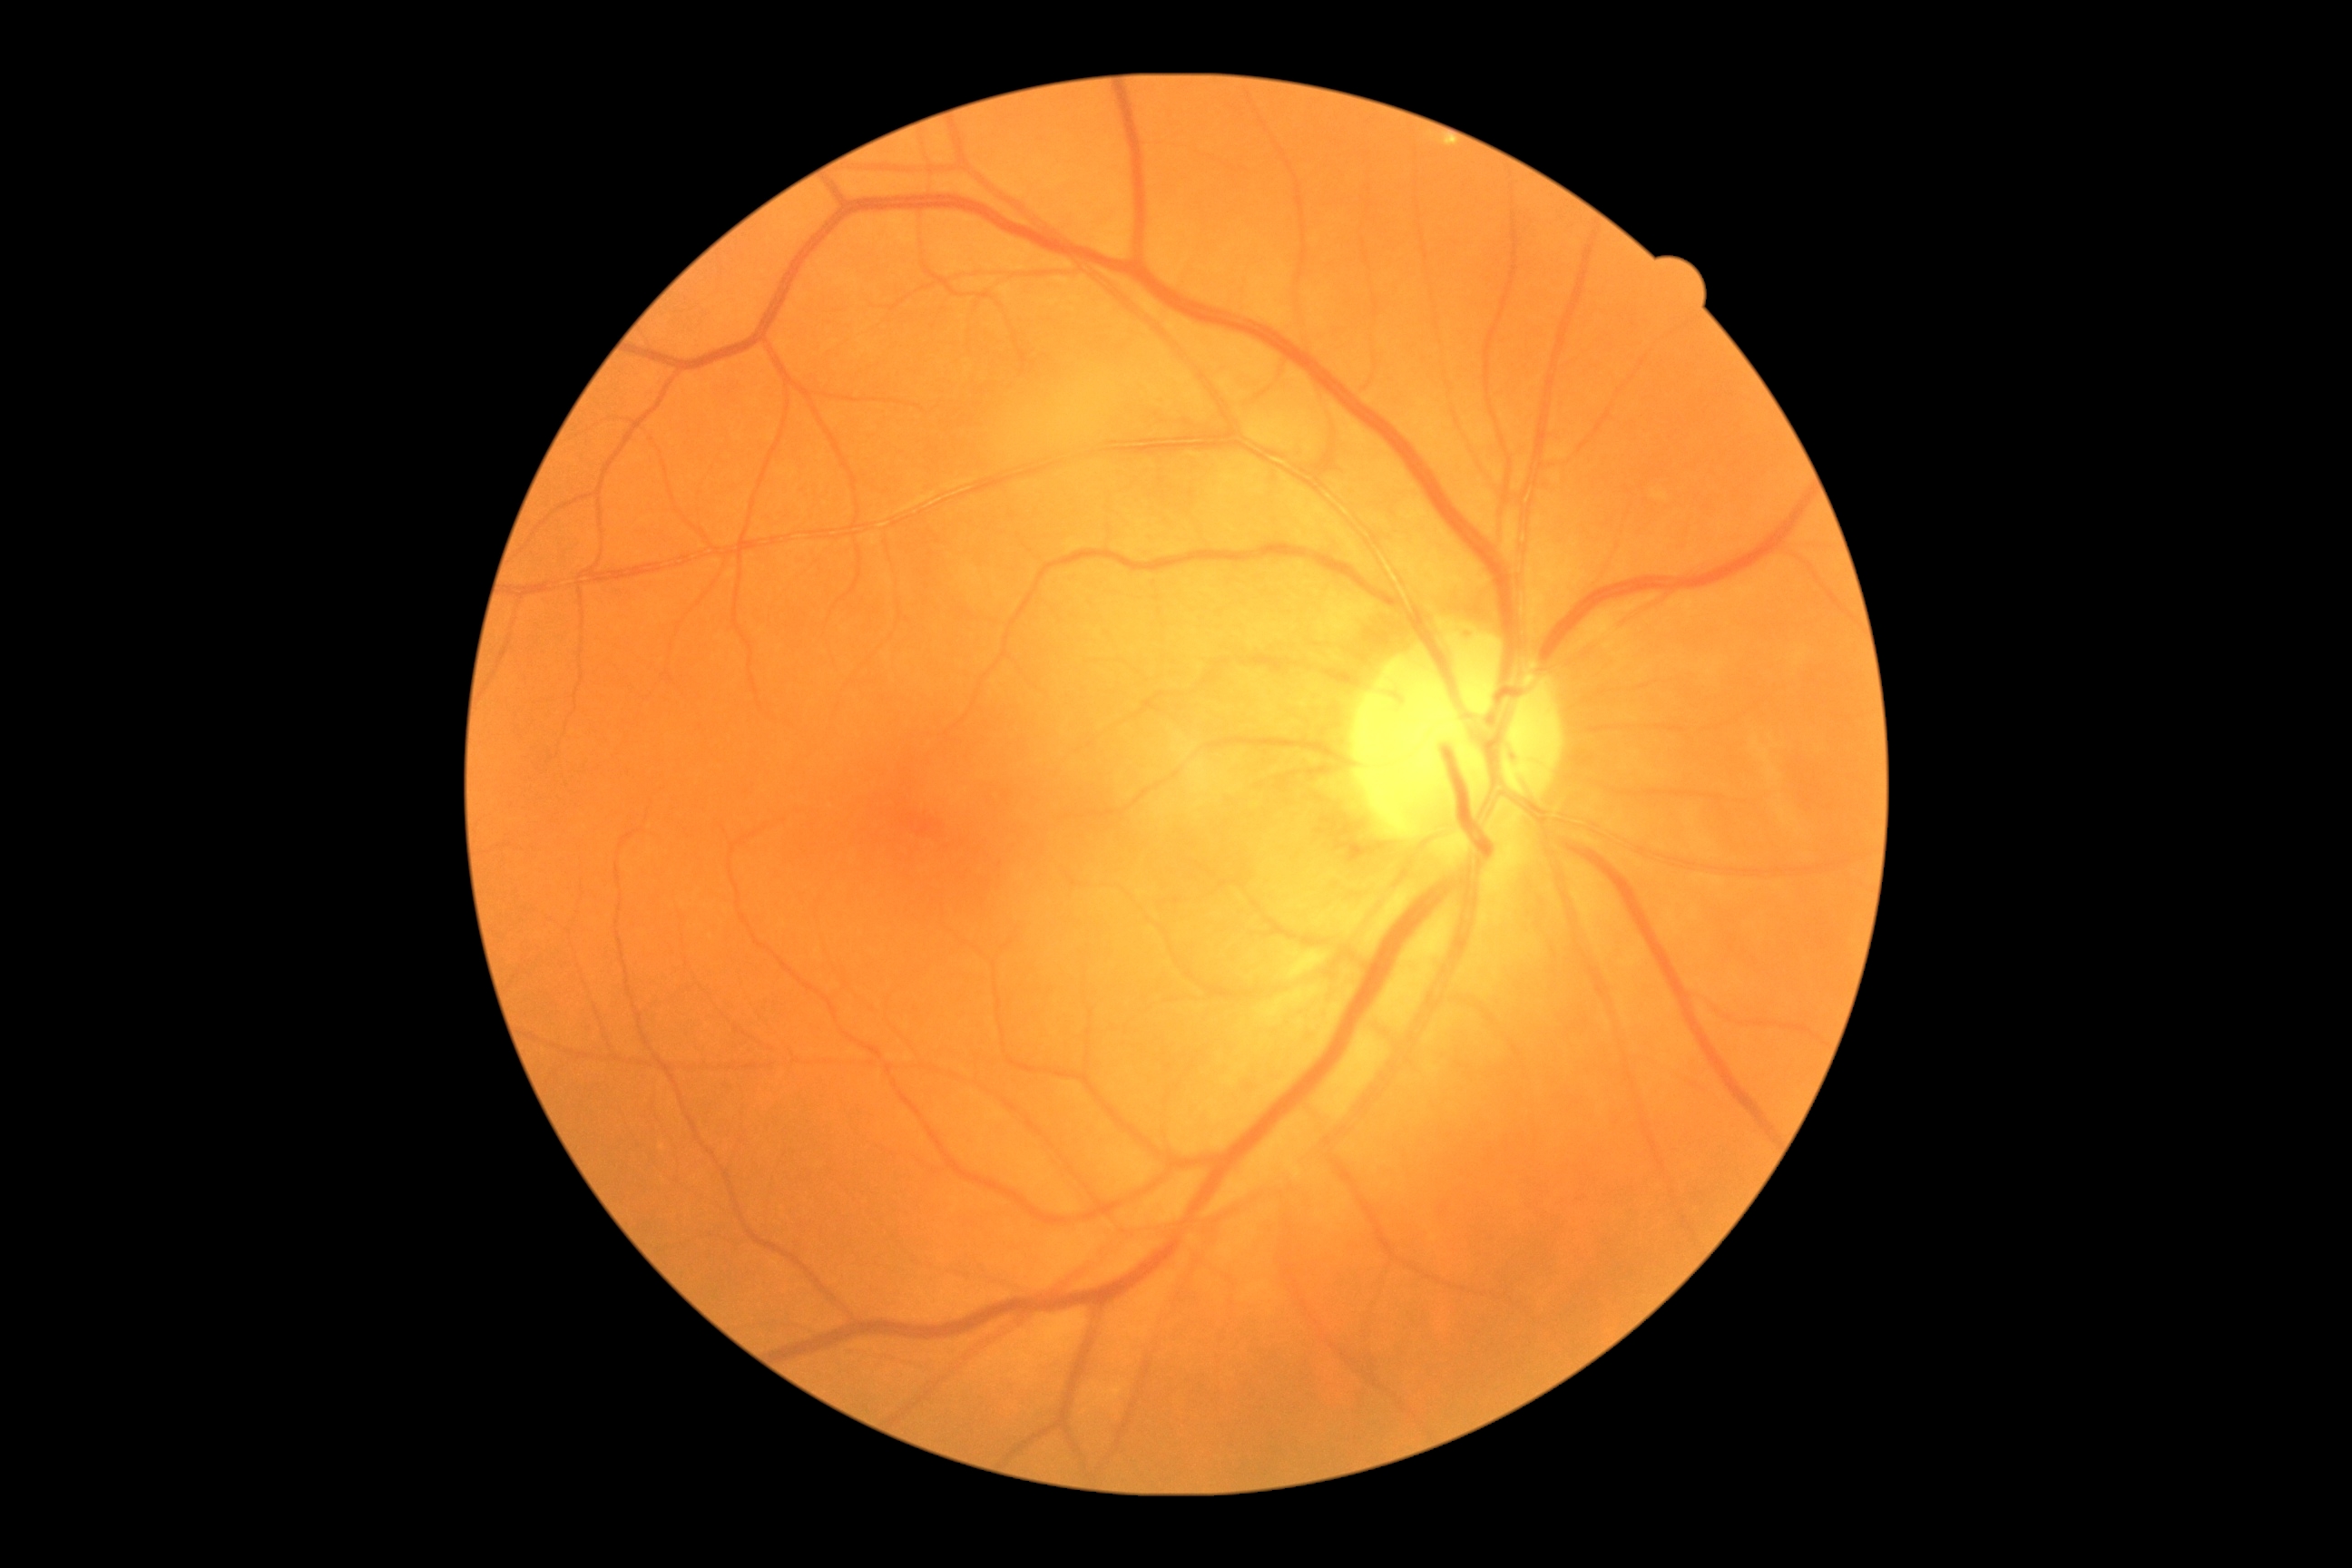

DR grade: 0 — no visible signs of diabetic retinopathy